Color fundus photograph · 45° FOV:
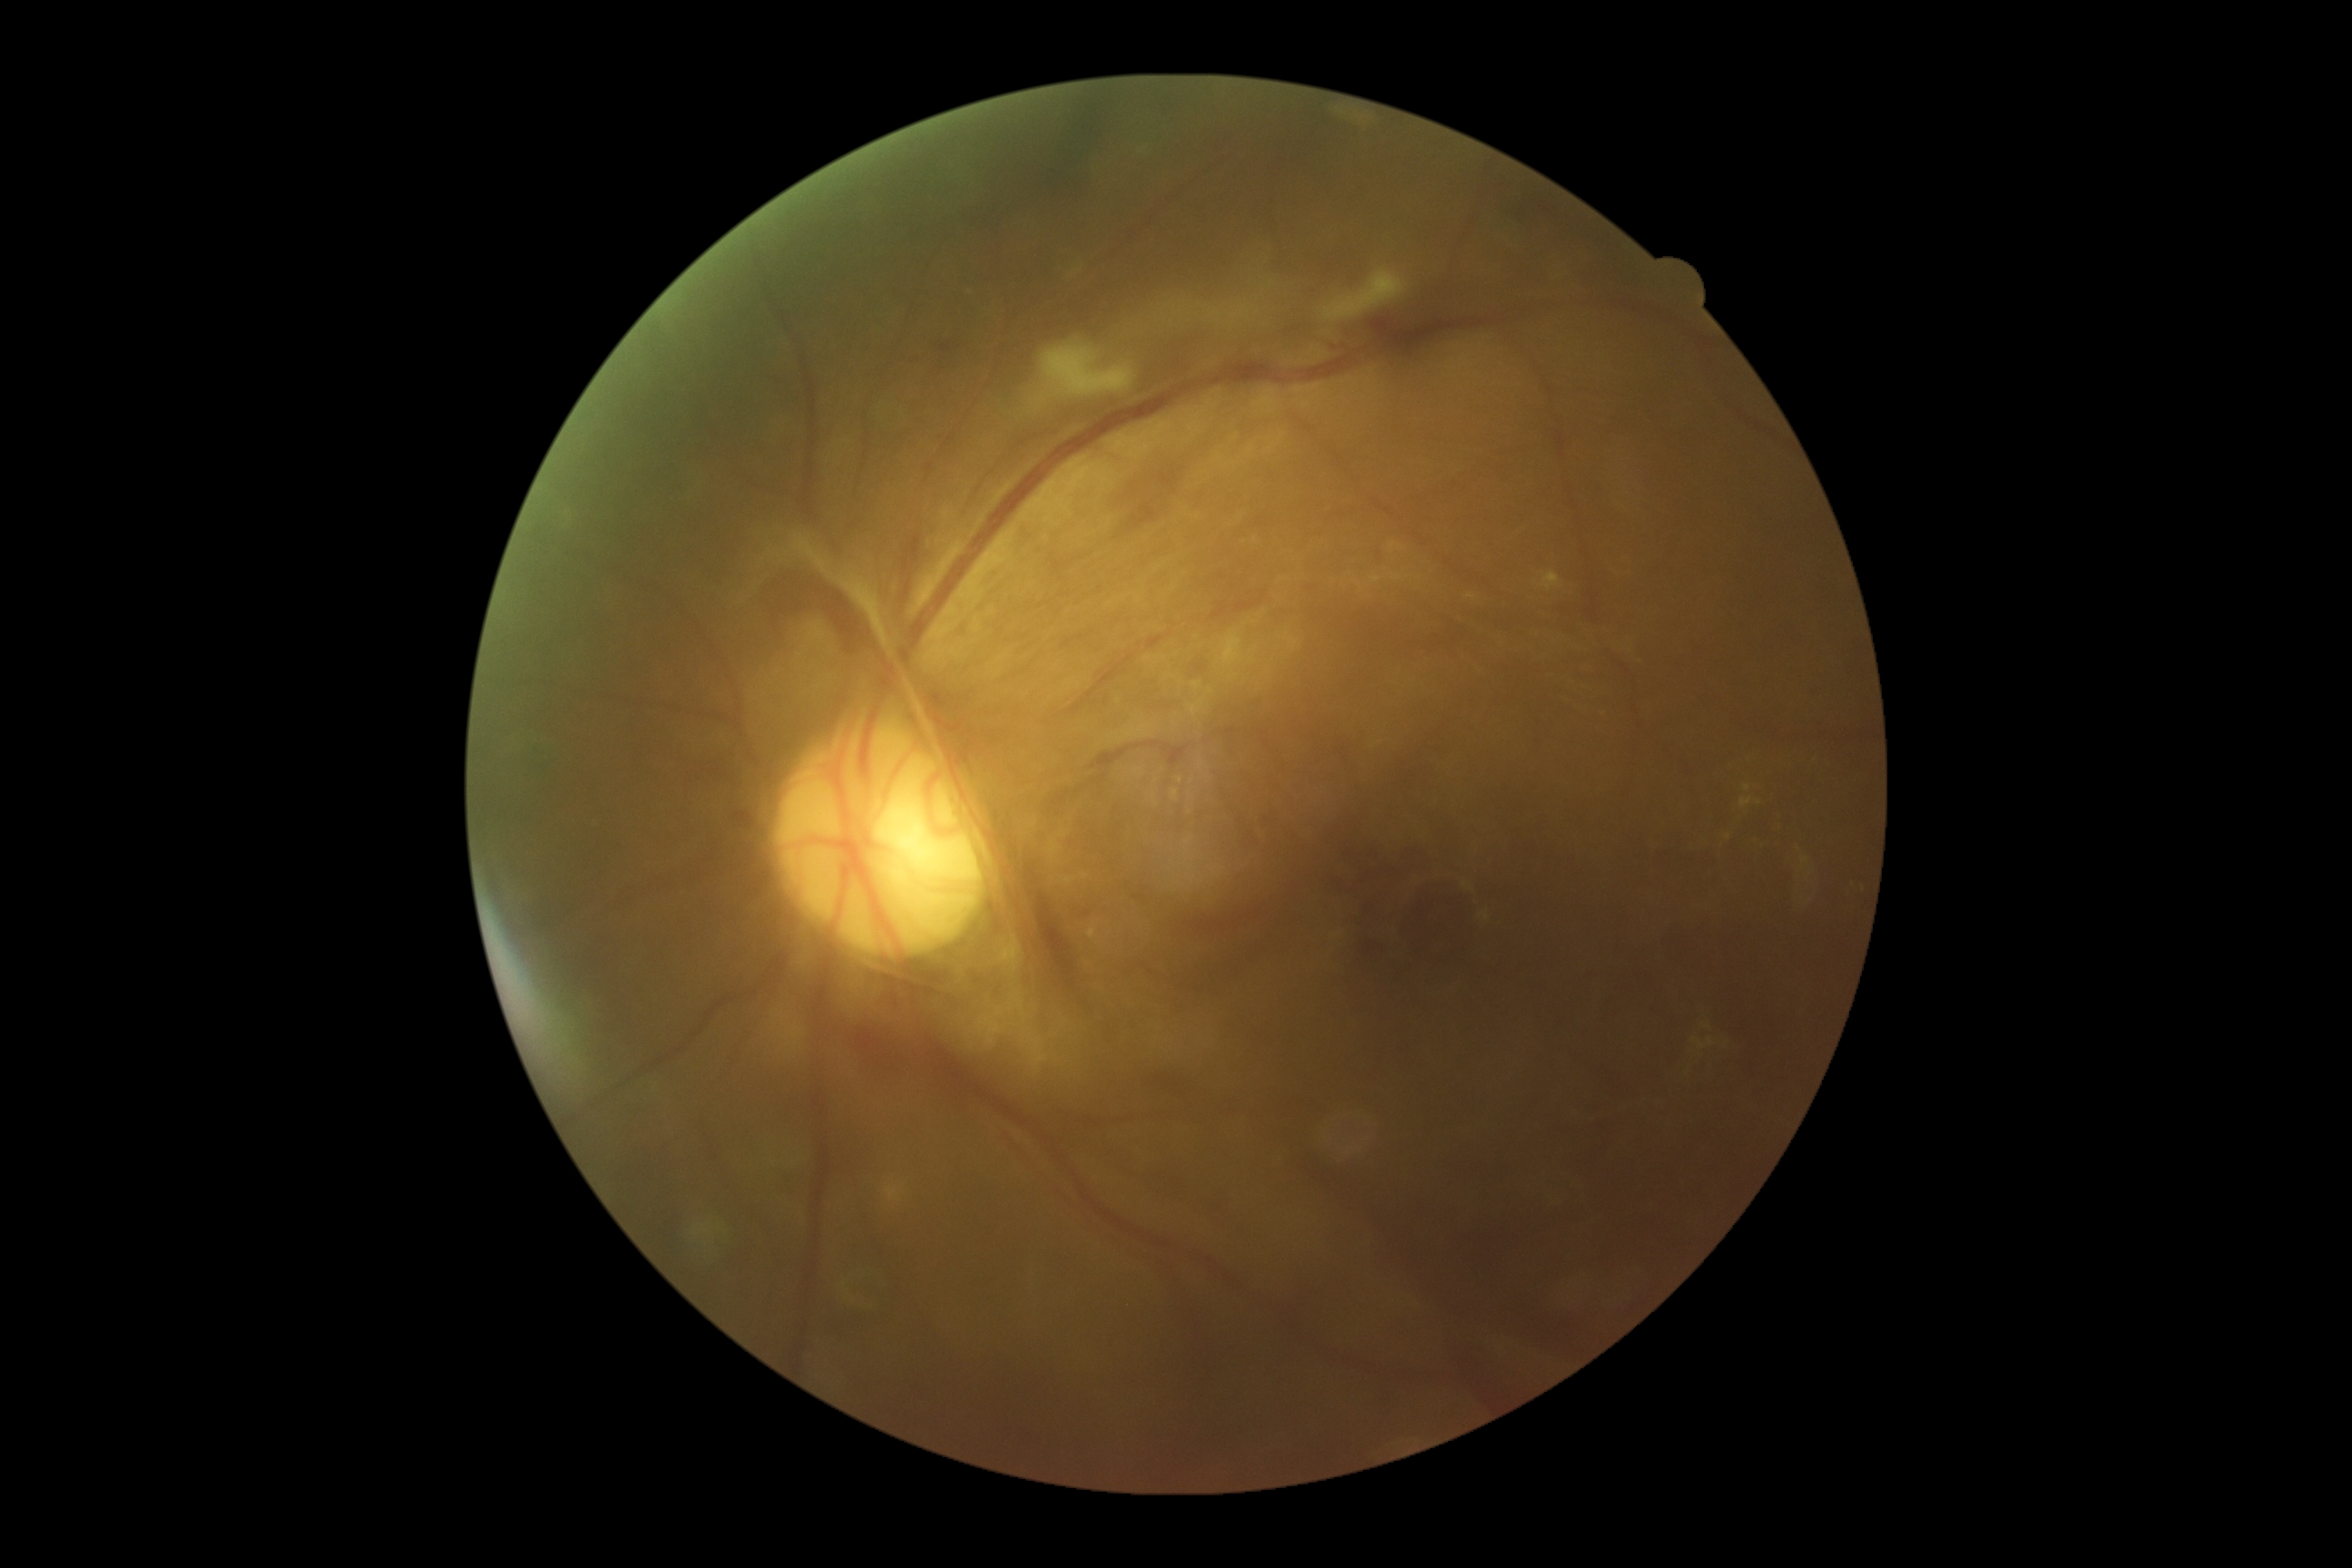
{"dr_grade": "PDR (grade 4)"}